Retinal fundus photograph, FOV: 45 degrees
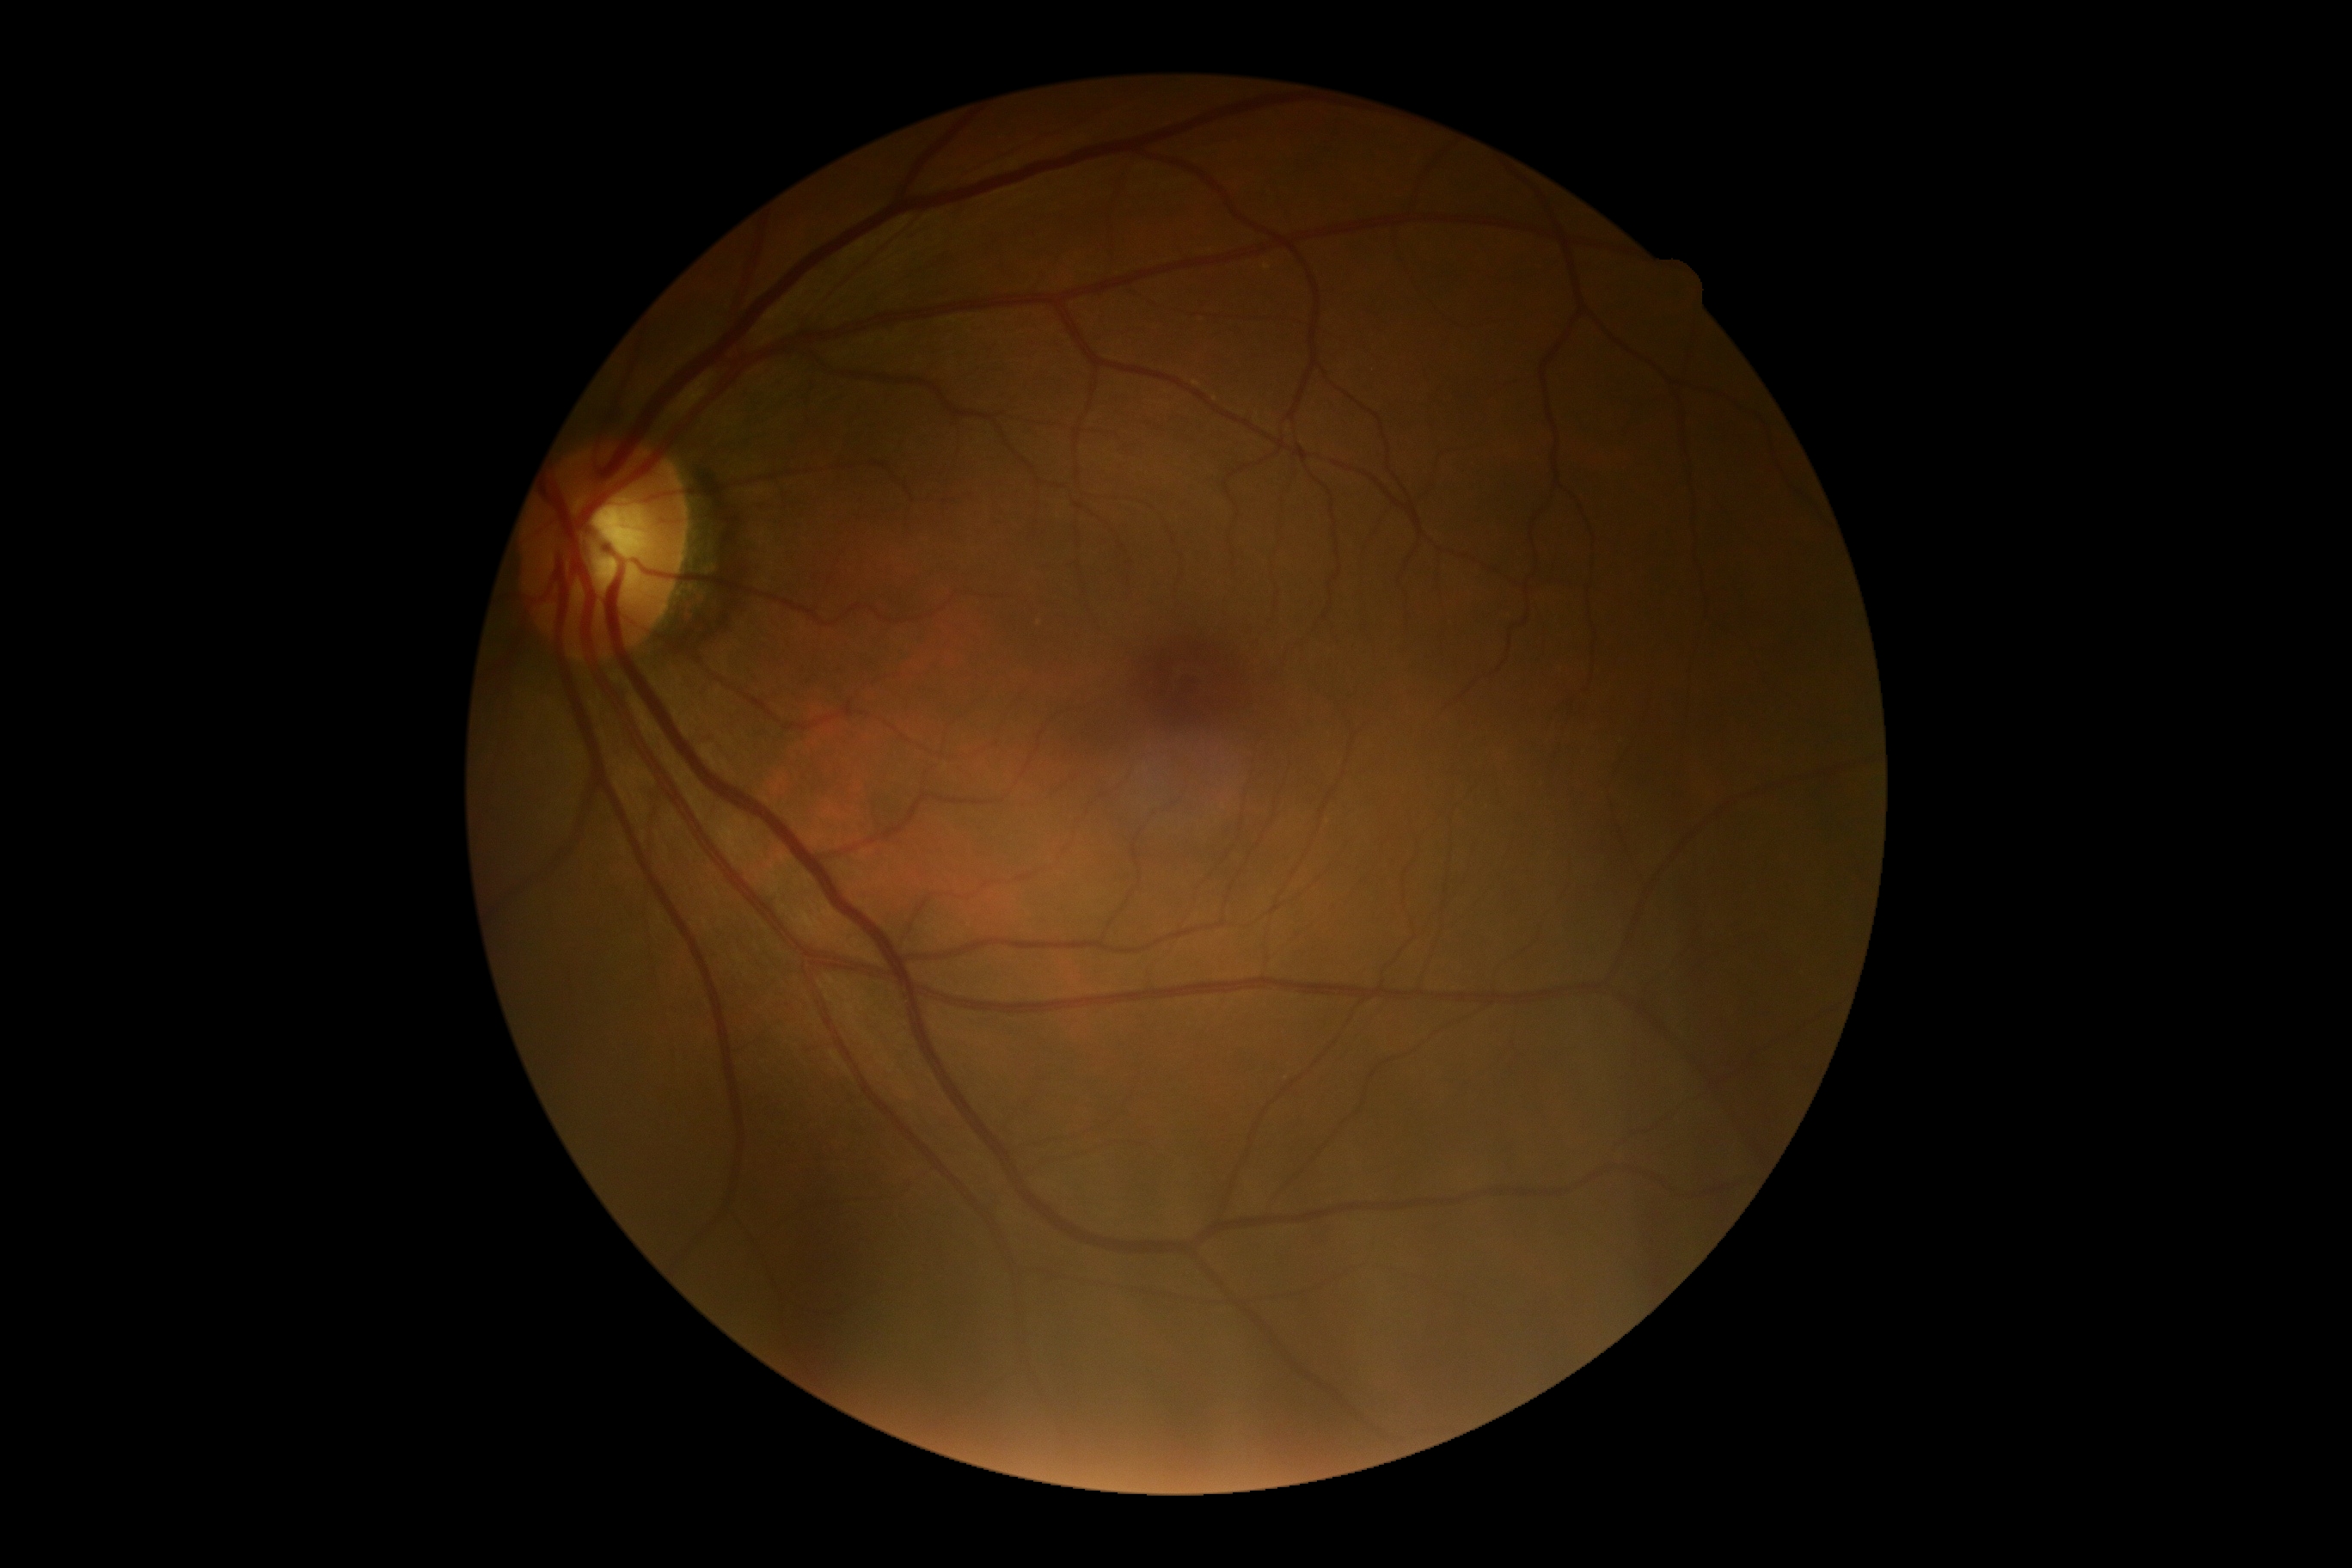 Diabetic retinopathy (DR) is grade 0.